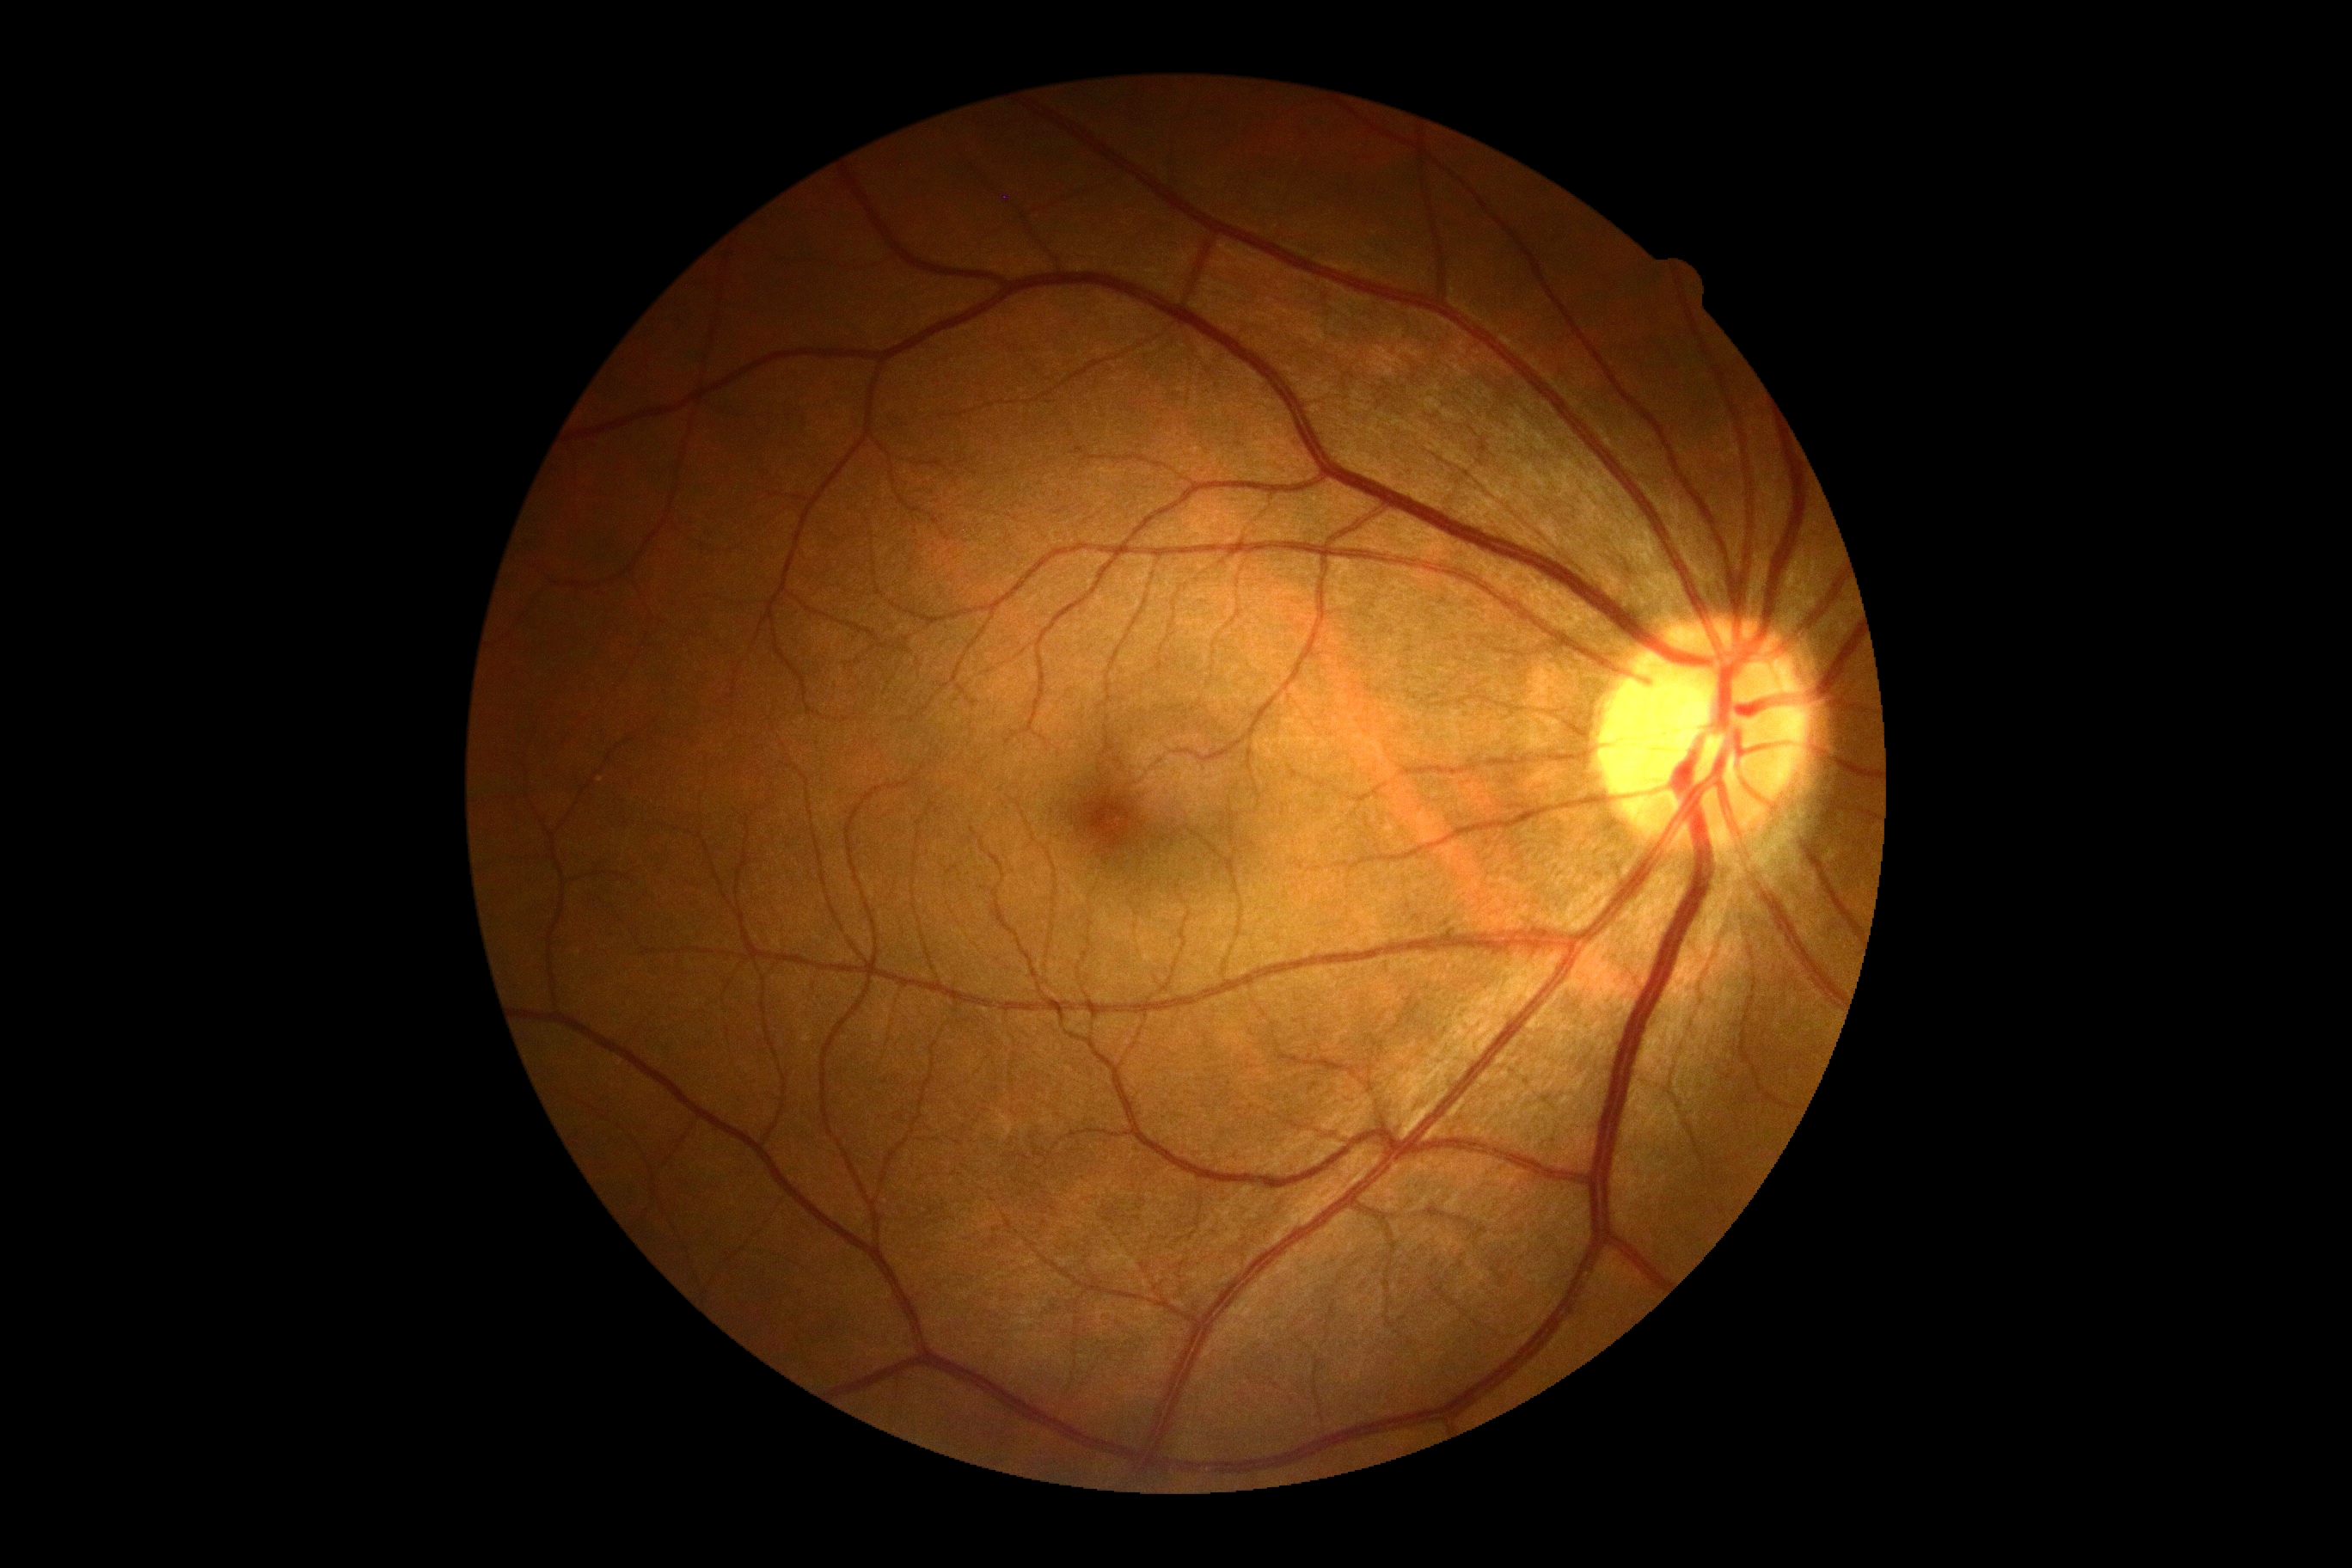 DR impression: no apparent DR | DR stage: grade 0 — no visible signs of diabetic retinopathy.